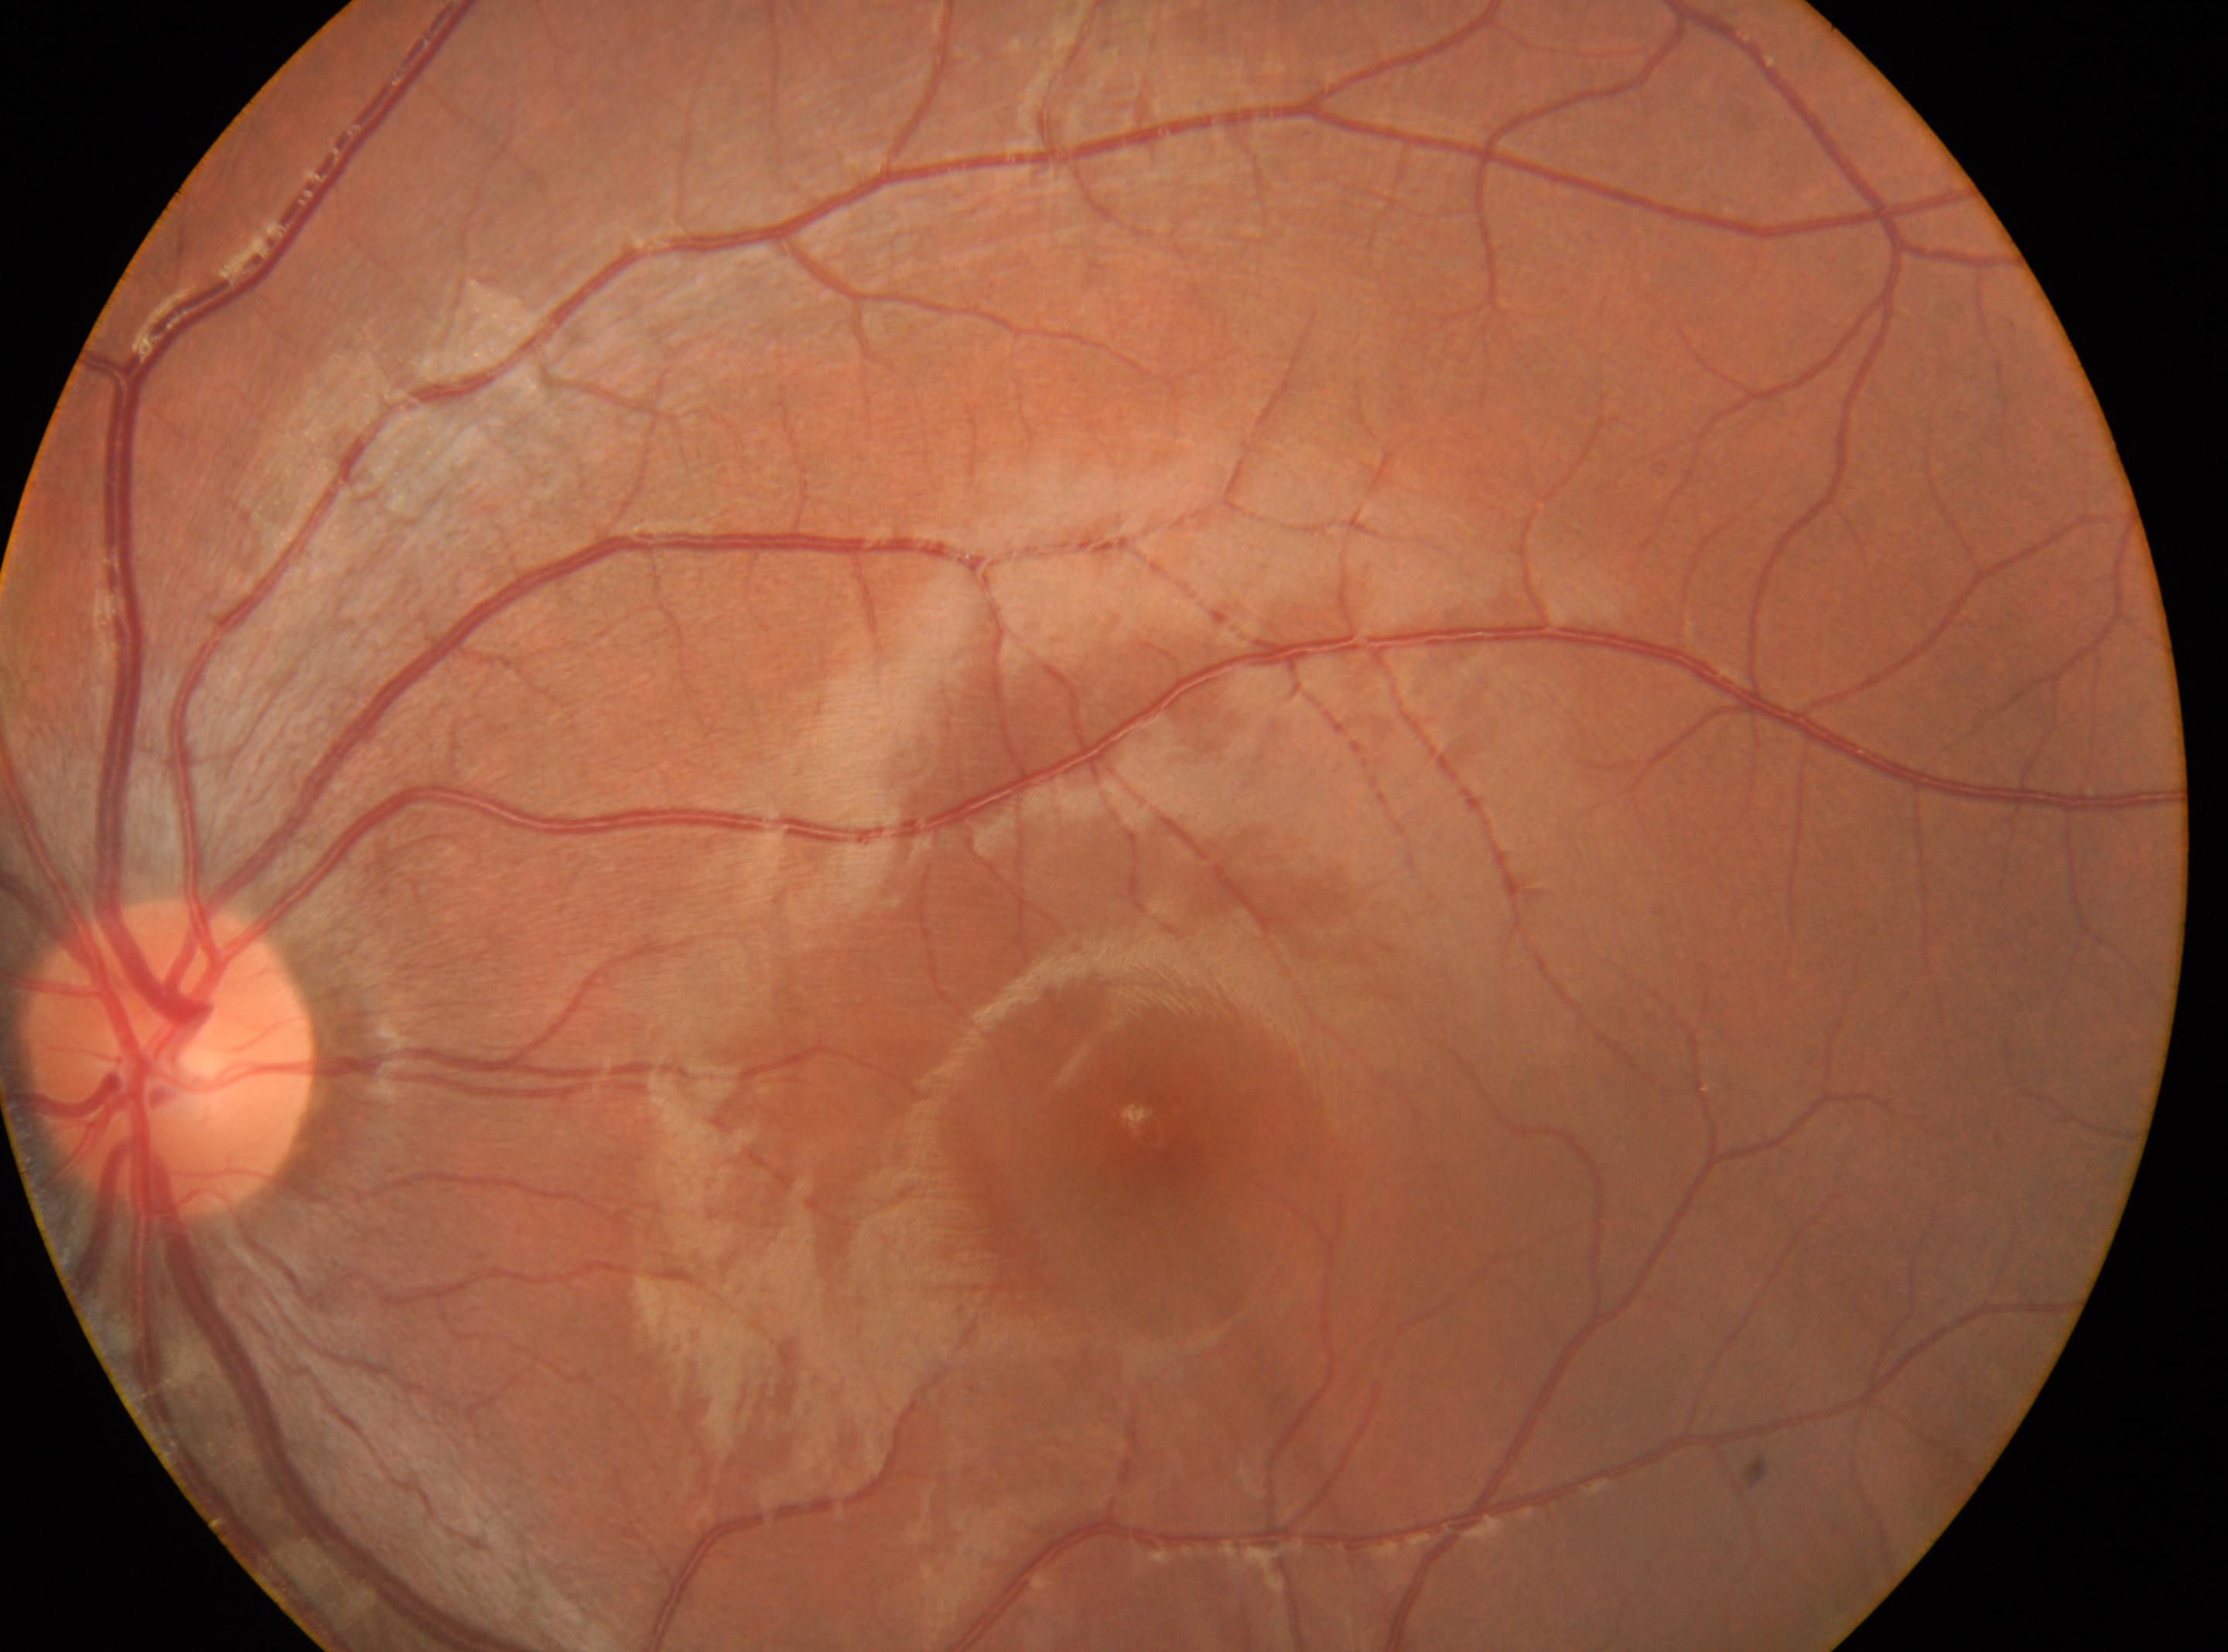 ONH: [169, 1056] | left | the fovea: [1146, 1131] | diabetic retinopathy grade: no apparent diabetic retinopathy (0).